Optic nerve head crop: 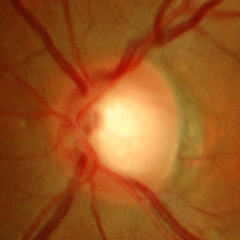 Q: Glaucoma assessment?
A: No — no glaucomatous findings.